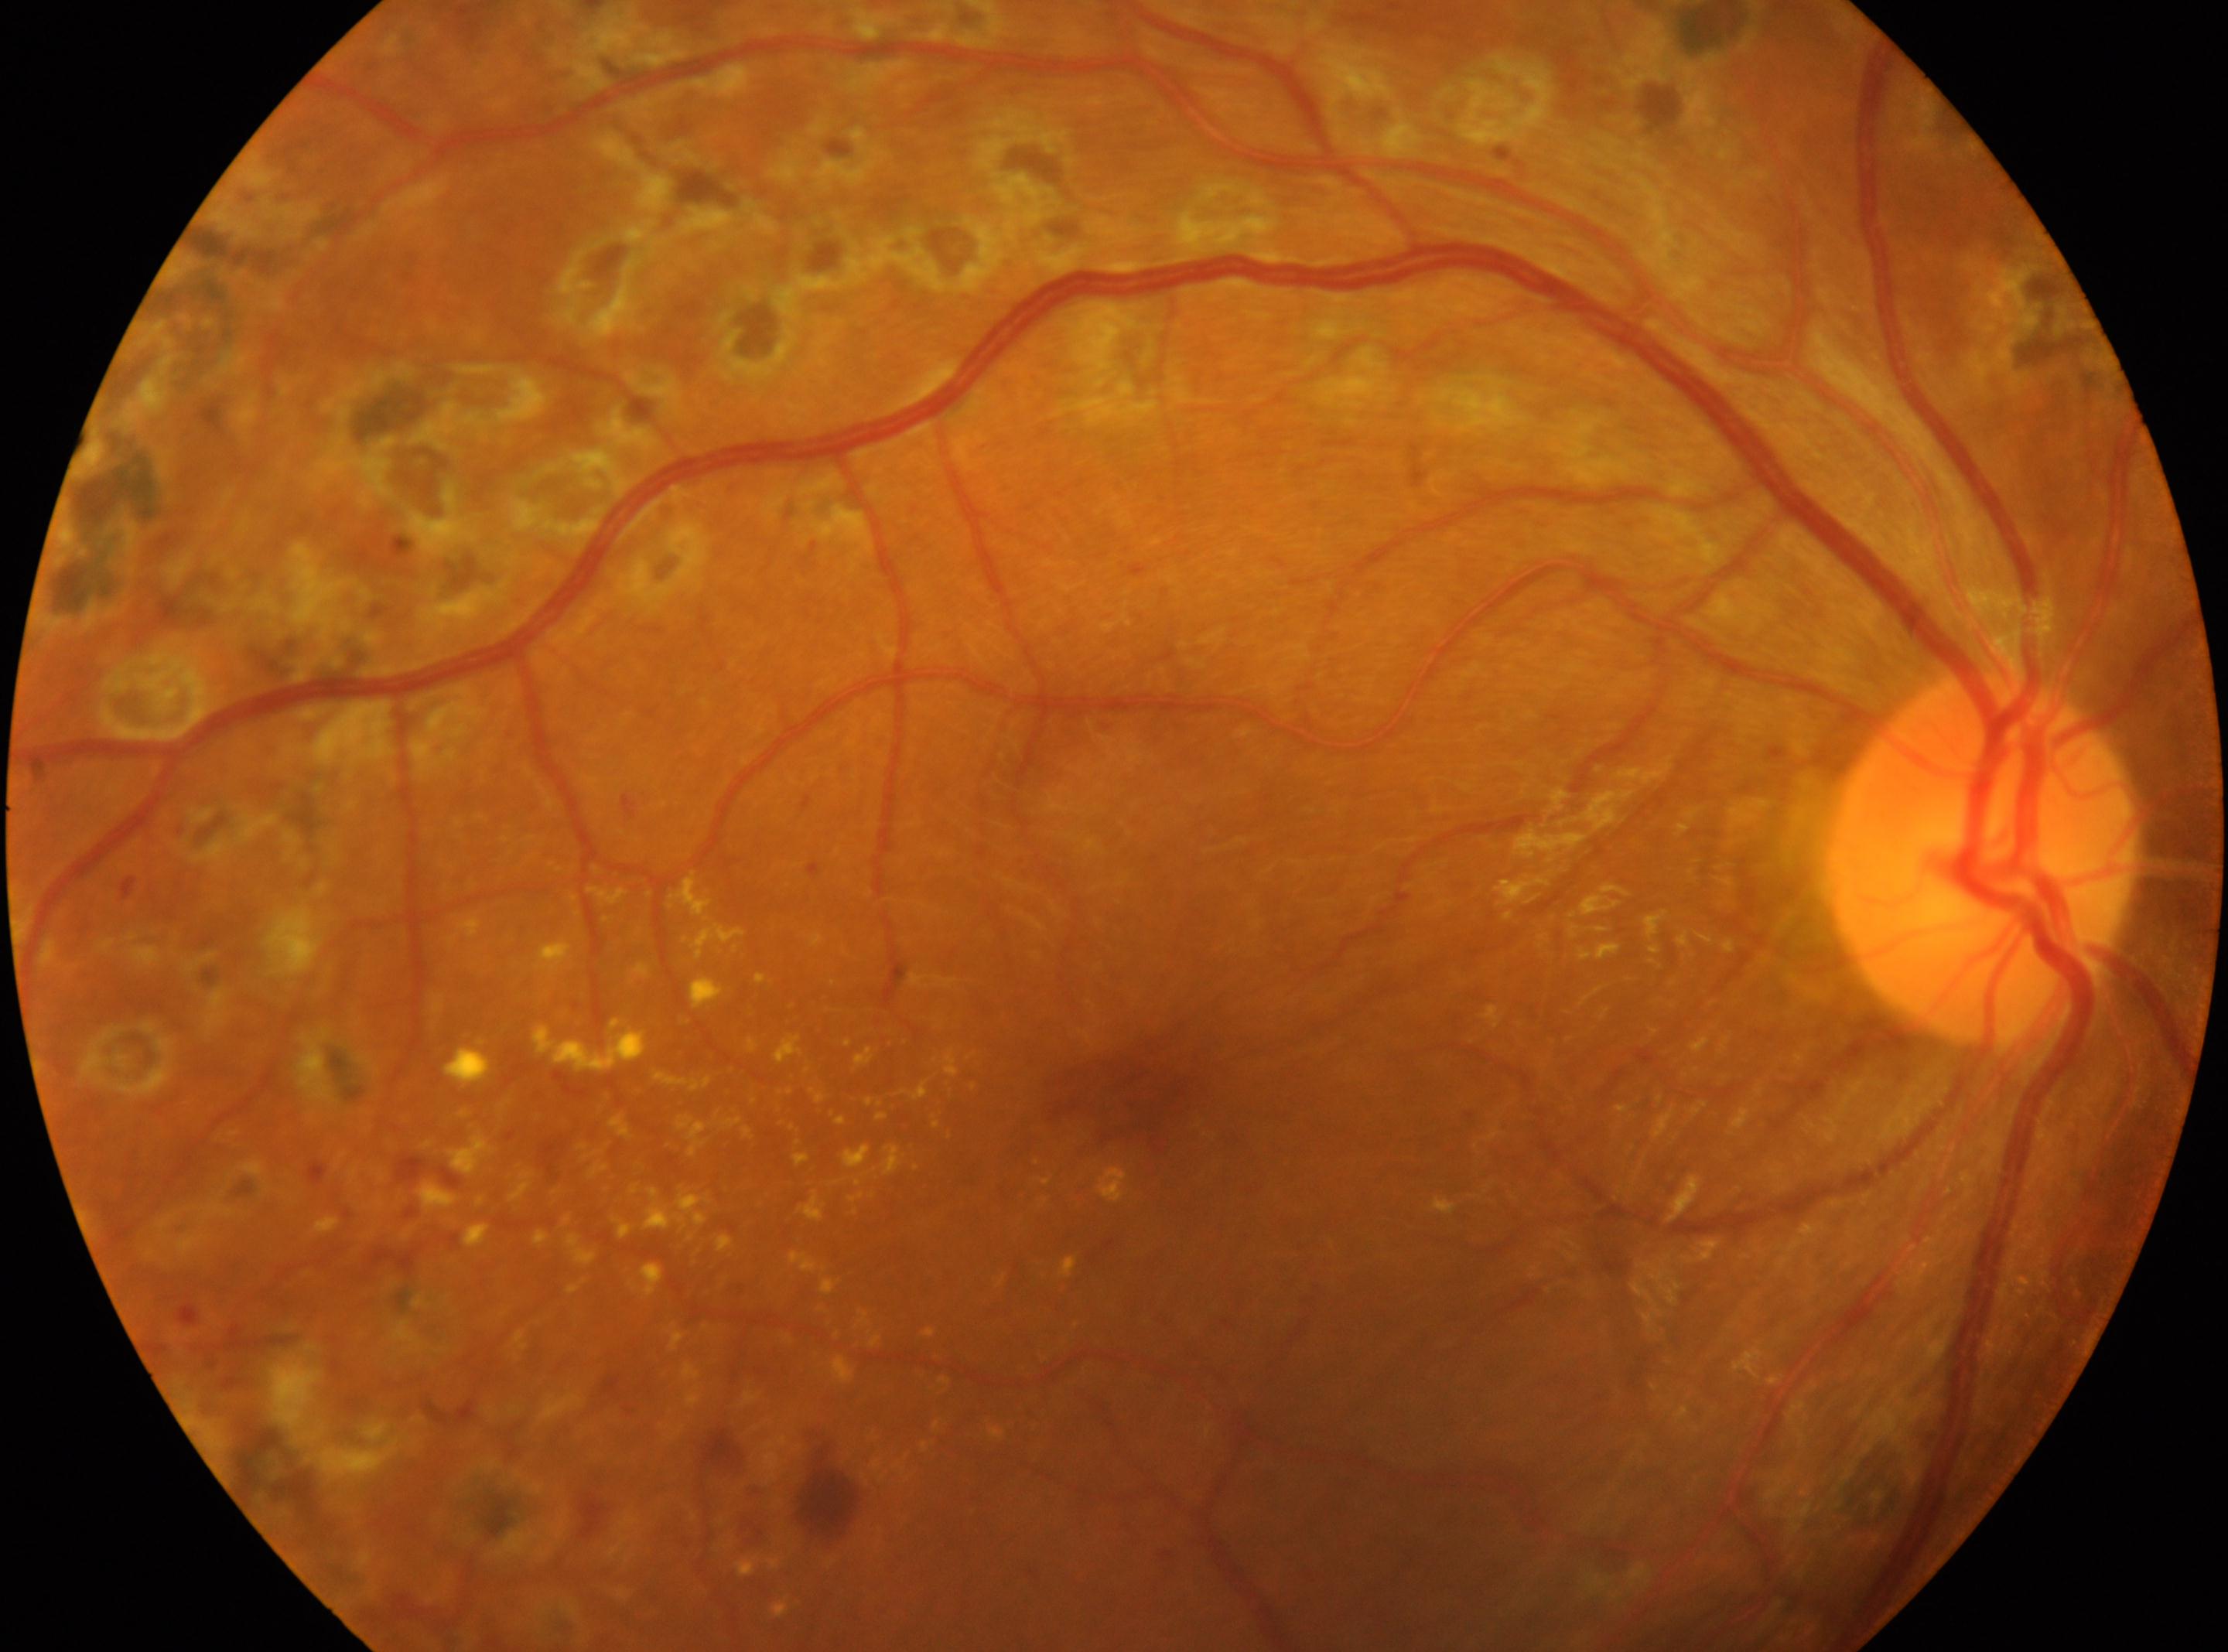 Fovea: [1131, 1091]. Diabetic retinopathy grade is laser-treated DR. This is the right eye. ONH located at [1982, 859].